848x848px; nonmydriatic; color fundus photograph; graded on the modified Davis scale
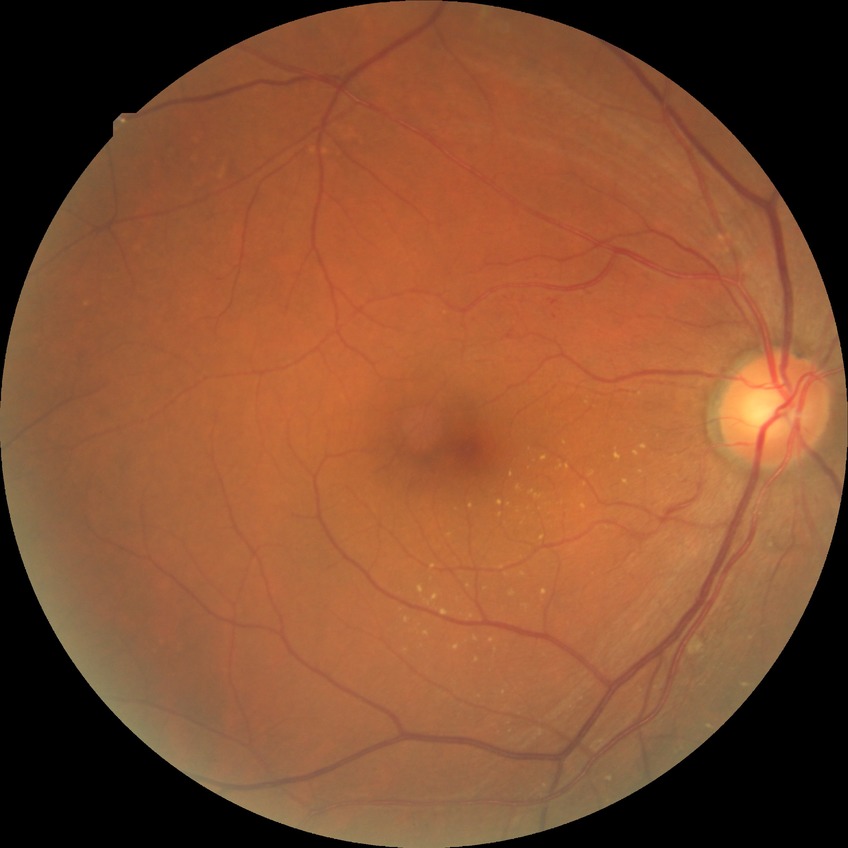
DR class: non-proliferative diabetic retinopathy.
Diabetic retinopathy (DR) is simple diabetic retinopathy (SDR).